Color fundus image:
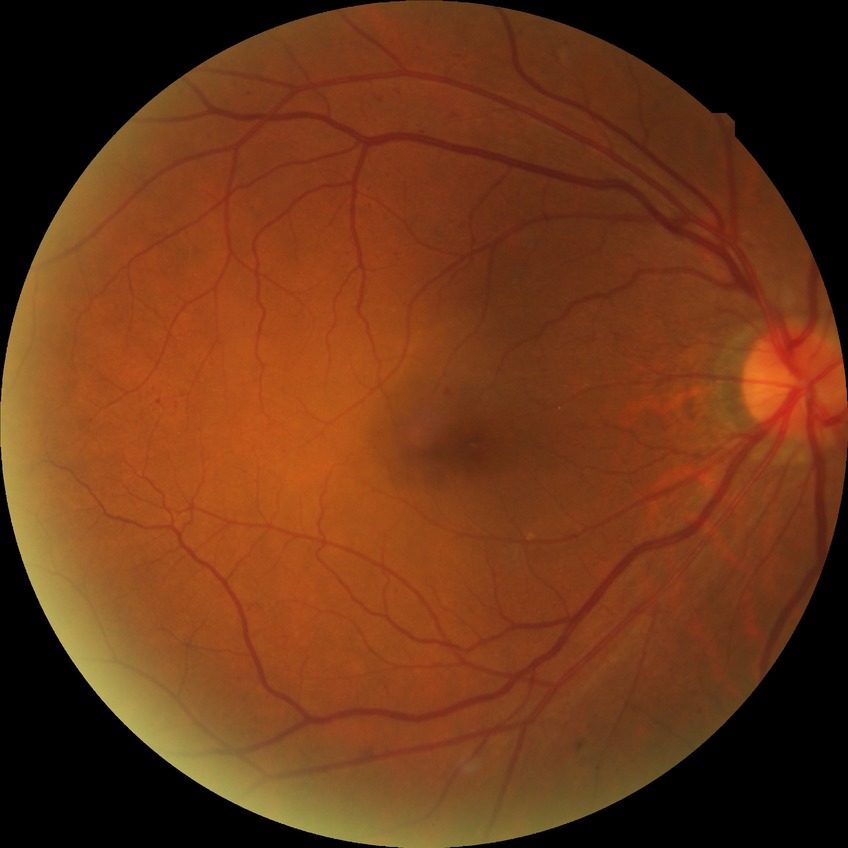 Disease class: non-proliferative diabetic retinopathy. Diabetic retinopathy (DR) is SDR (simple diabetic retinopathy).